Macula-centered field. Mydriatic (tropicamide phenylephrine 1.0%):
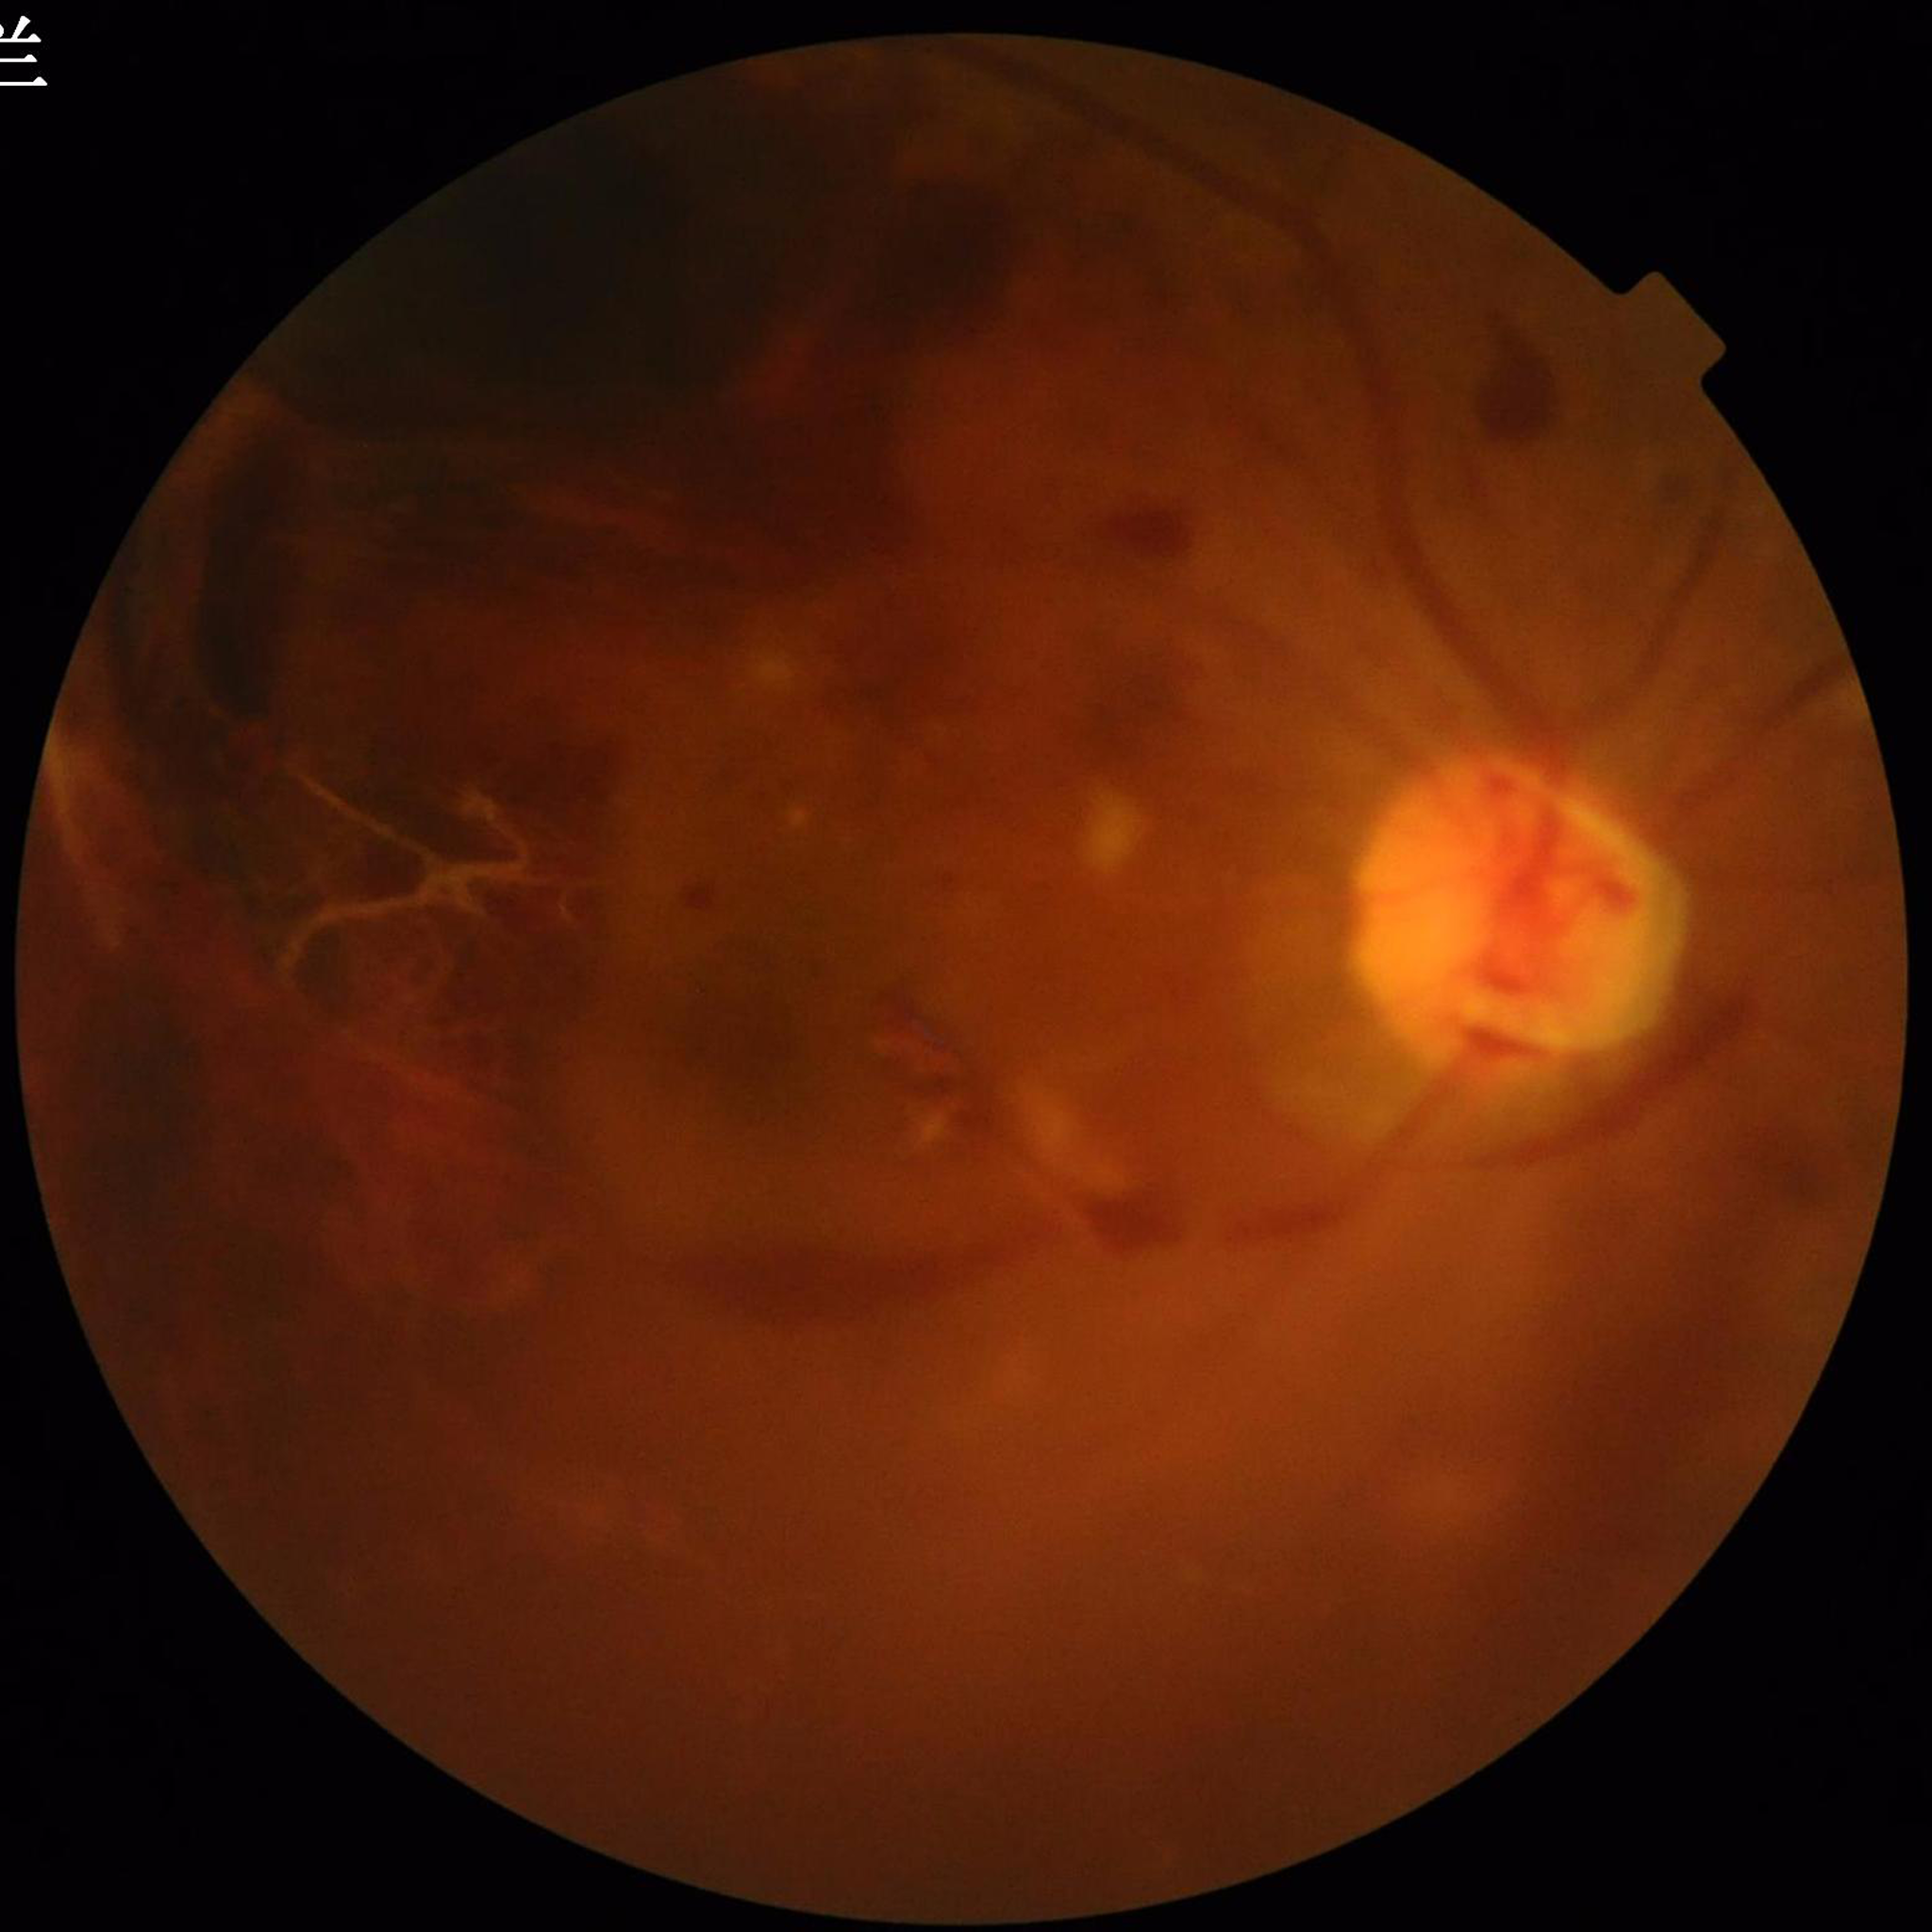
Image quality: issues noted — blur | Impression: diabetic retinopathy.